848x848px:
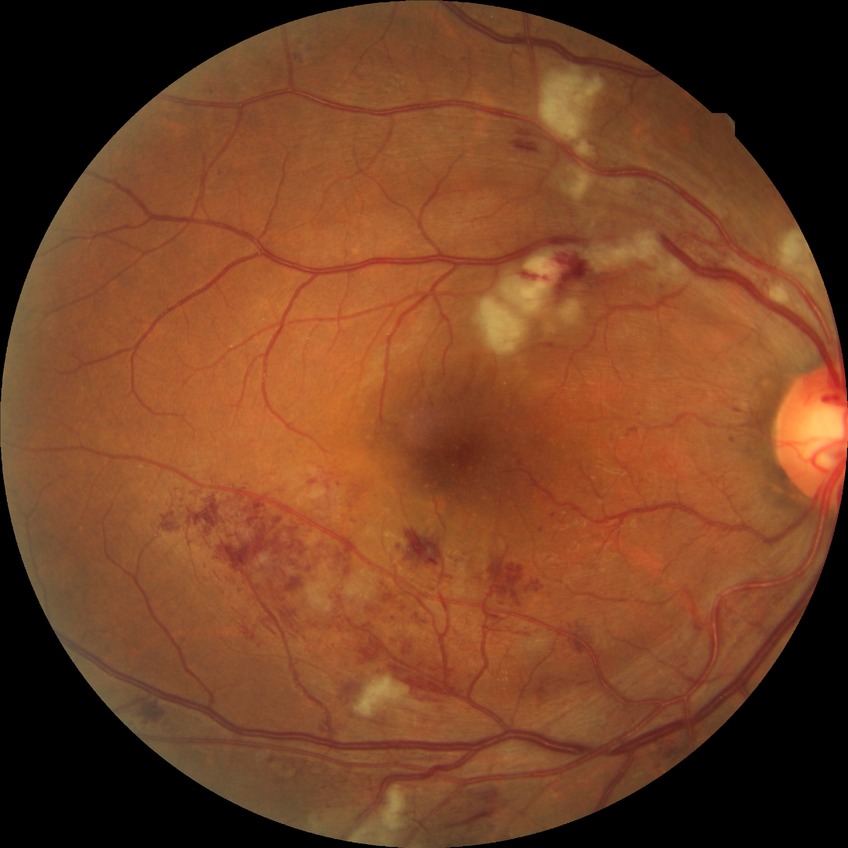

Diabetic retinopathy (DR): PPDR (pre-proliferative diabetic retinopathy).